2352 by 1568 pixels — 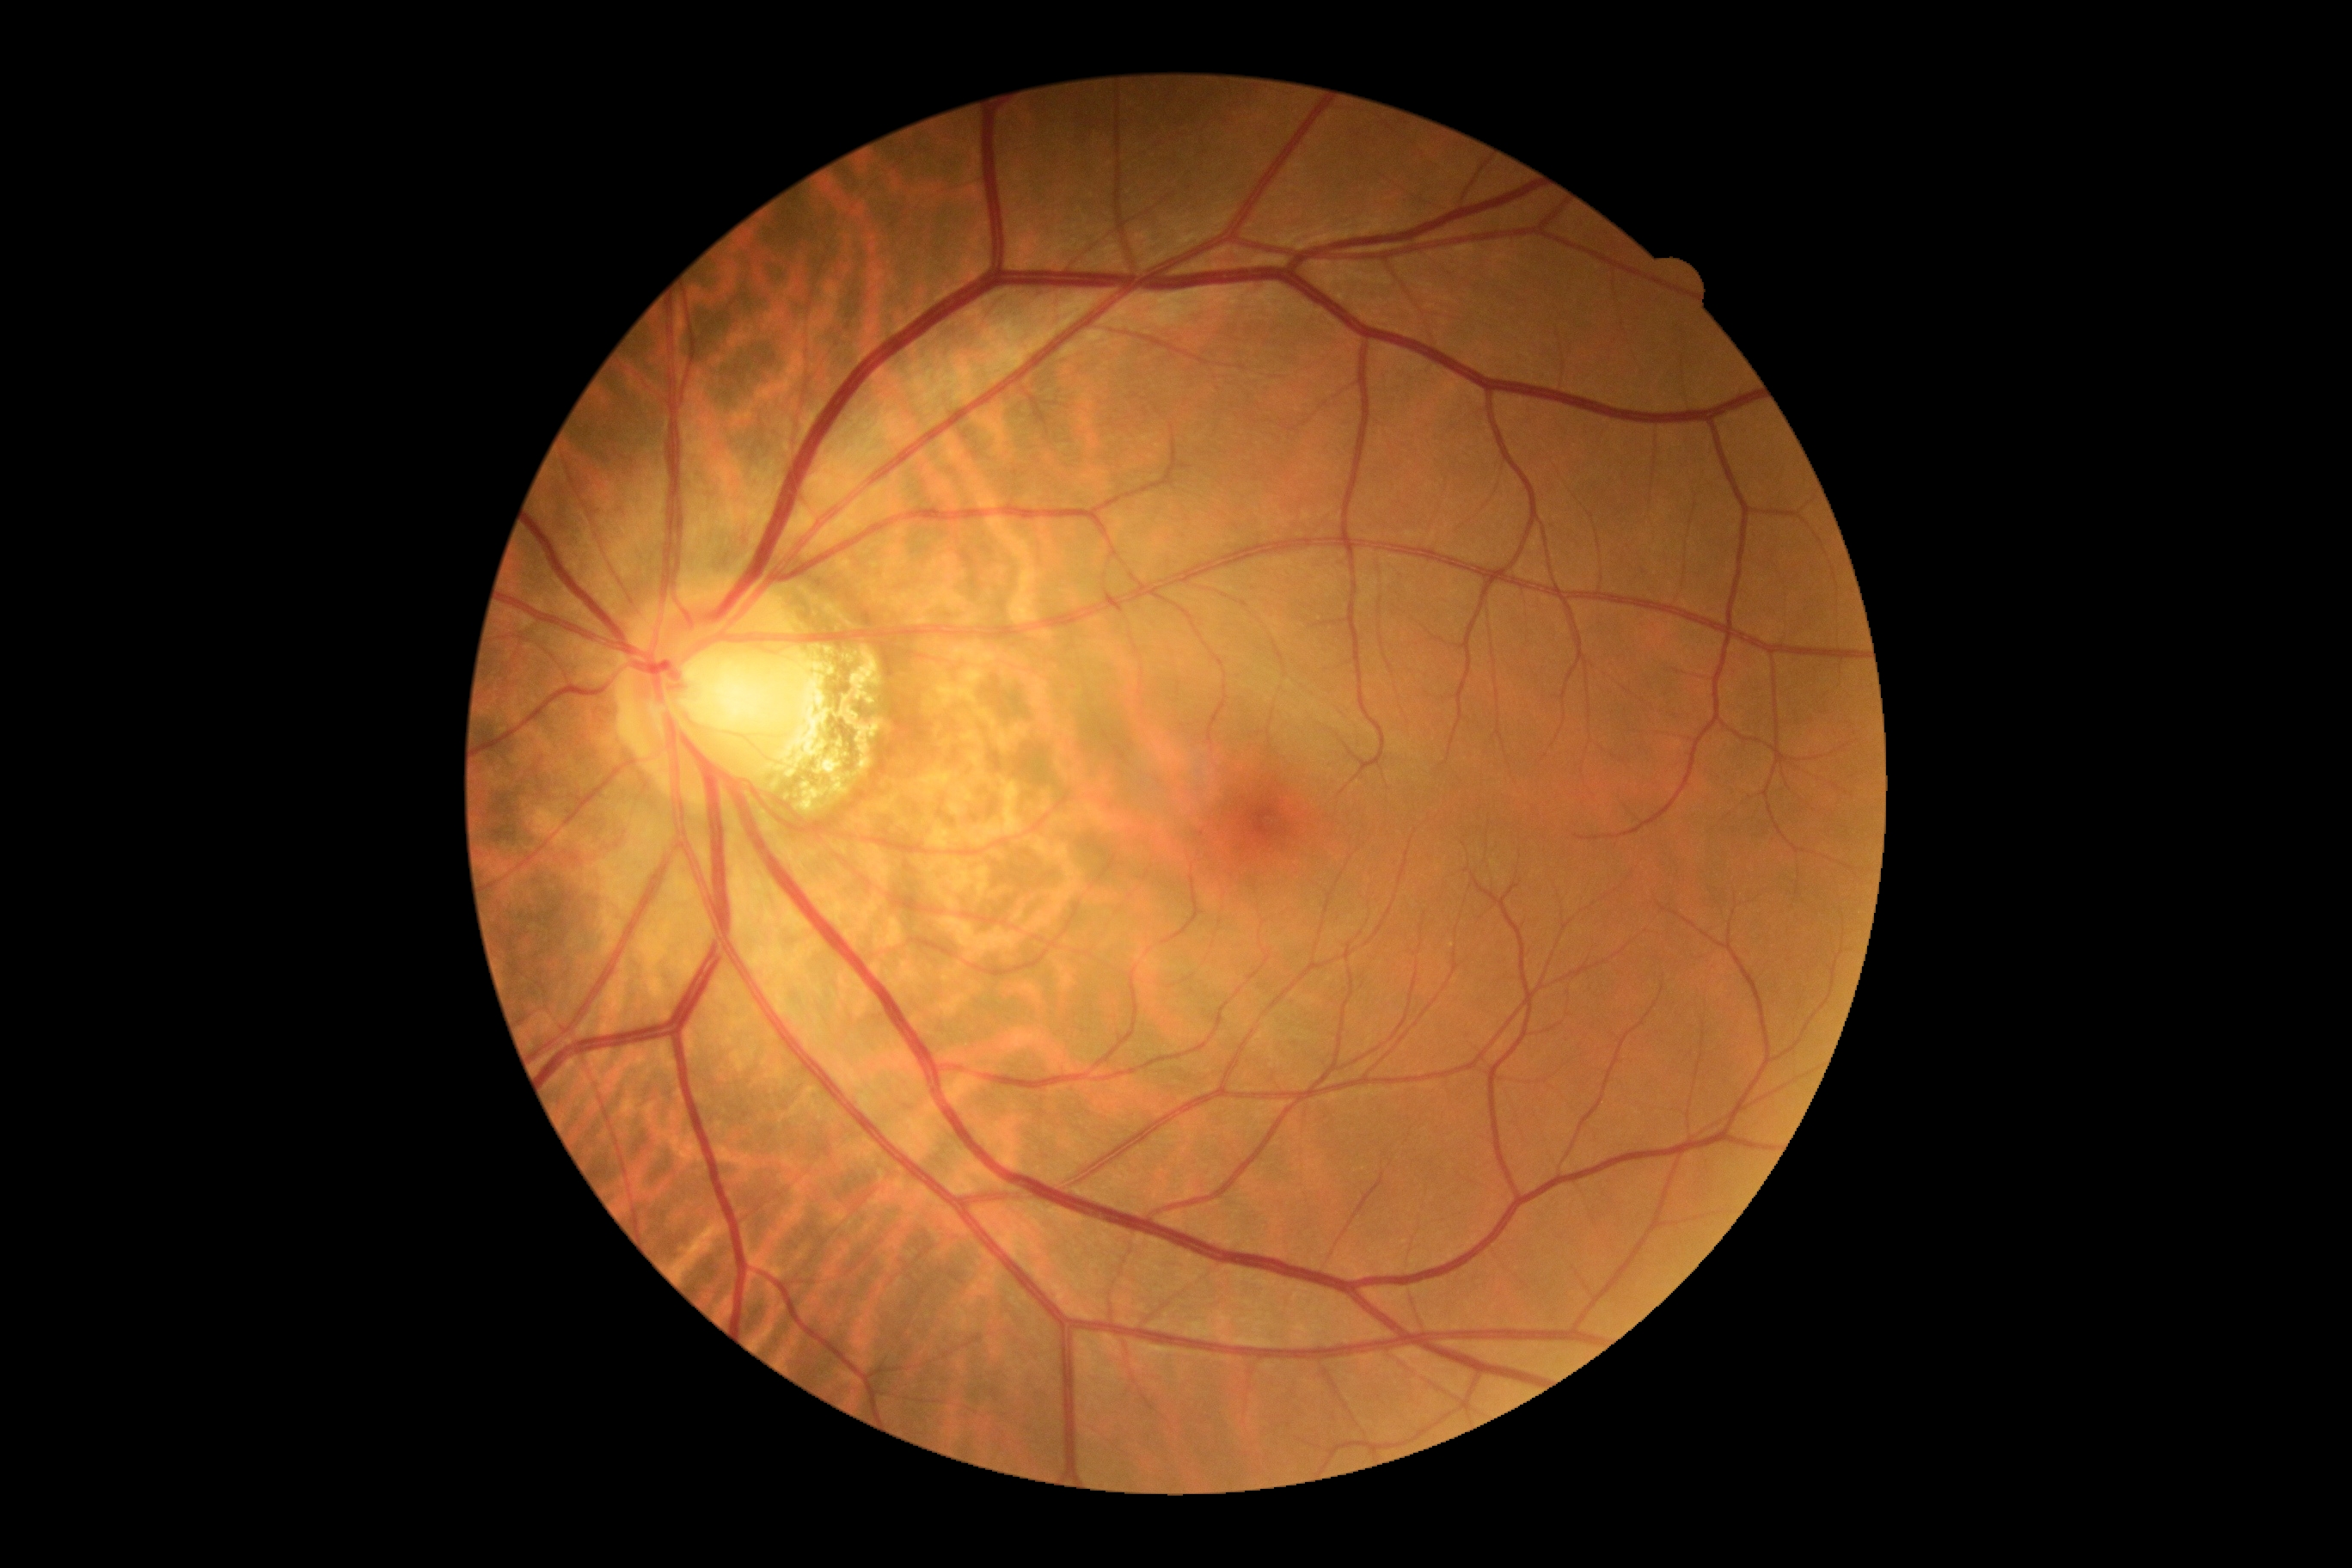
Diabetic retinopathy (DR) is no apparent retinopathy (grade 0). No apparent diabetic retinopathy.